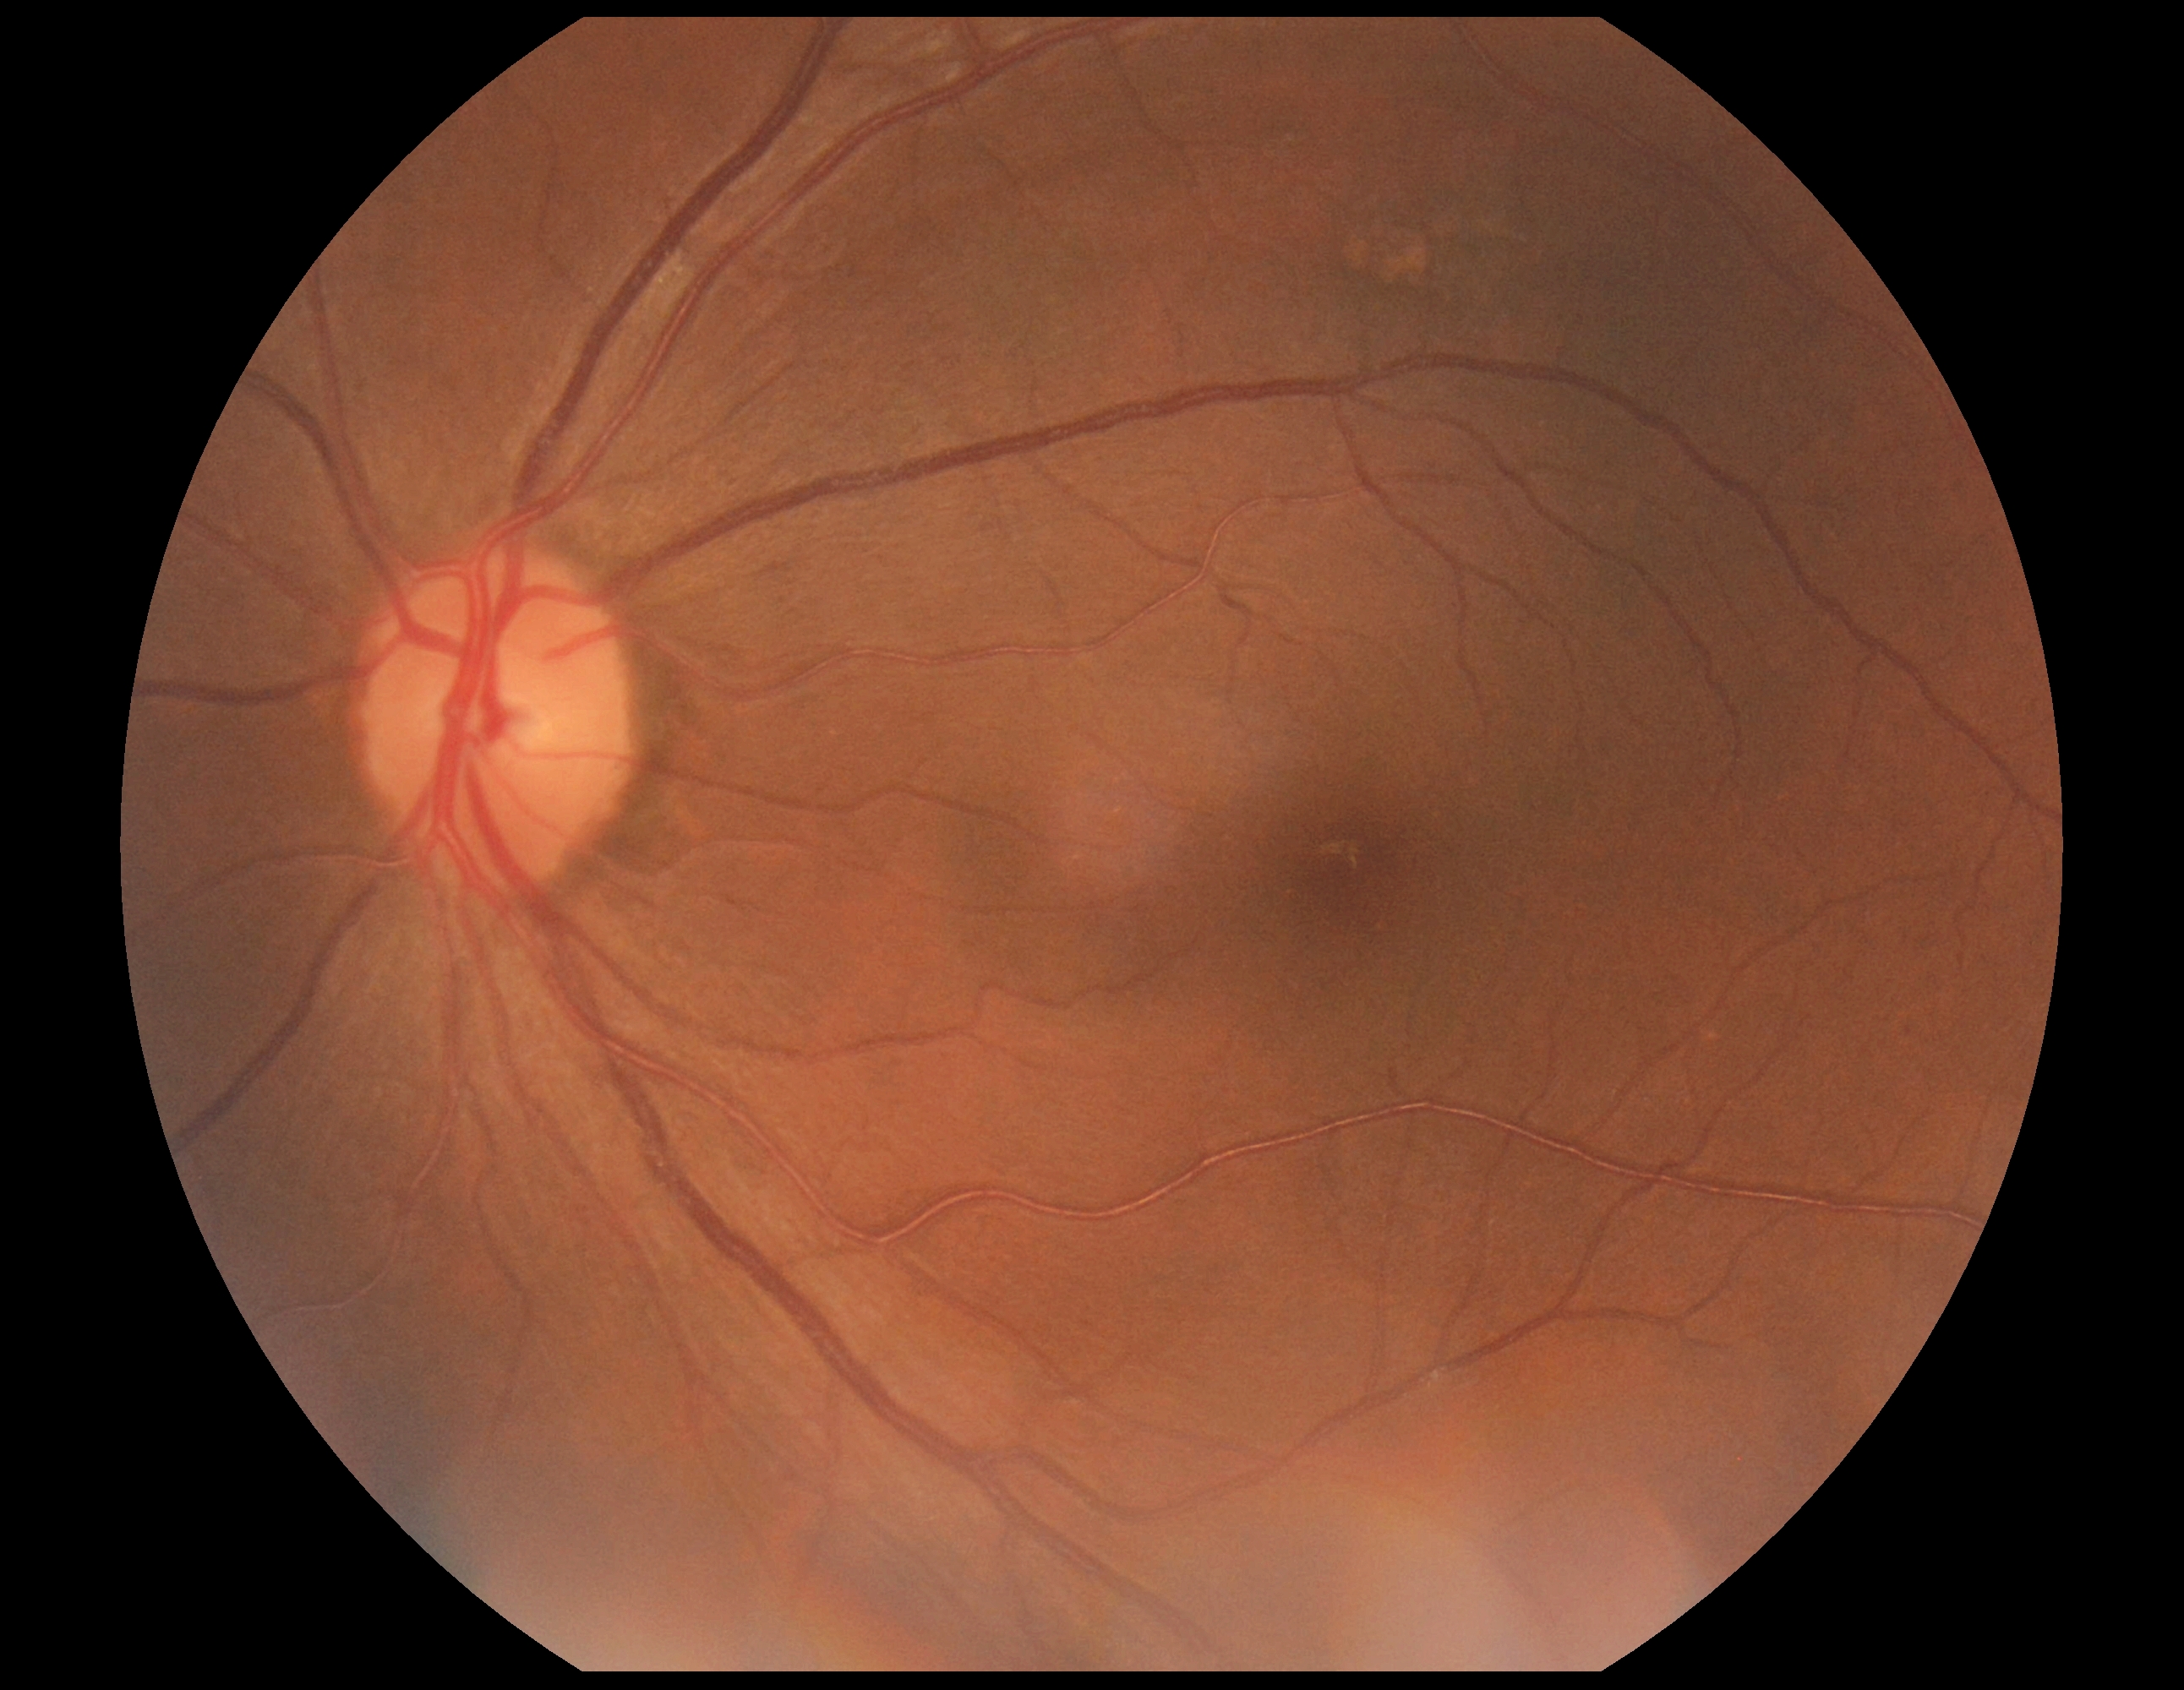 diabetic retinopathy grade: 0 (no apparent retinopathy).